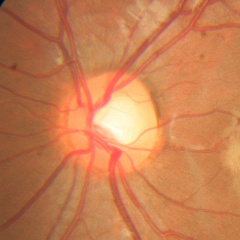 Q: Does this eye have glaucoma?
A: No glaucoma.